2346 by 1568 pixels.
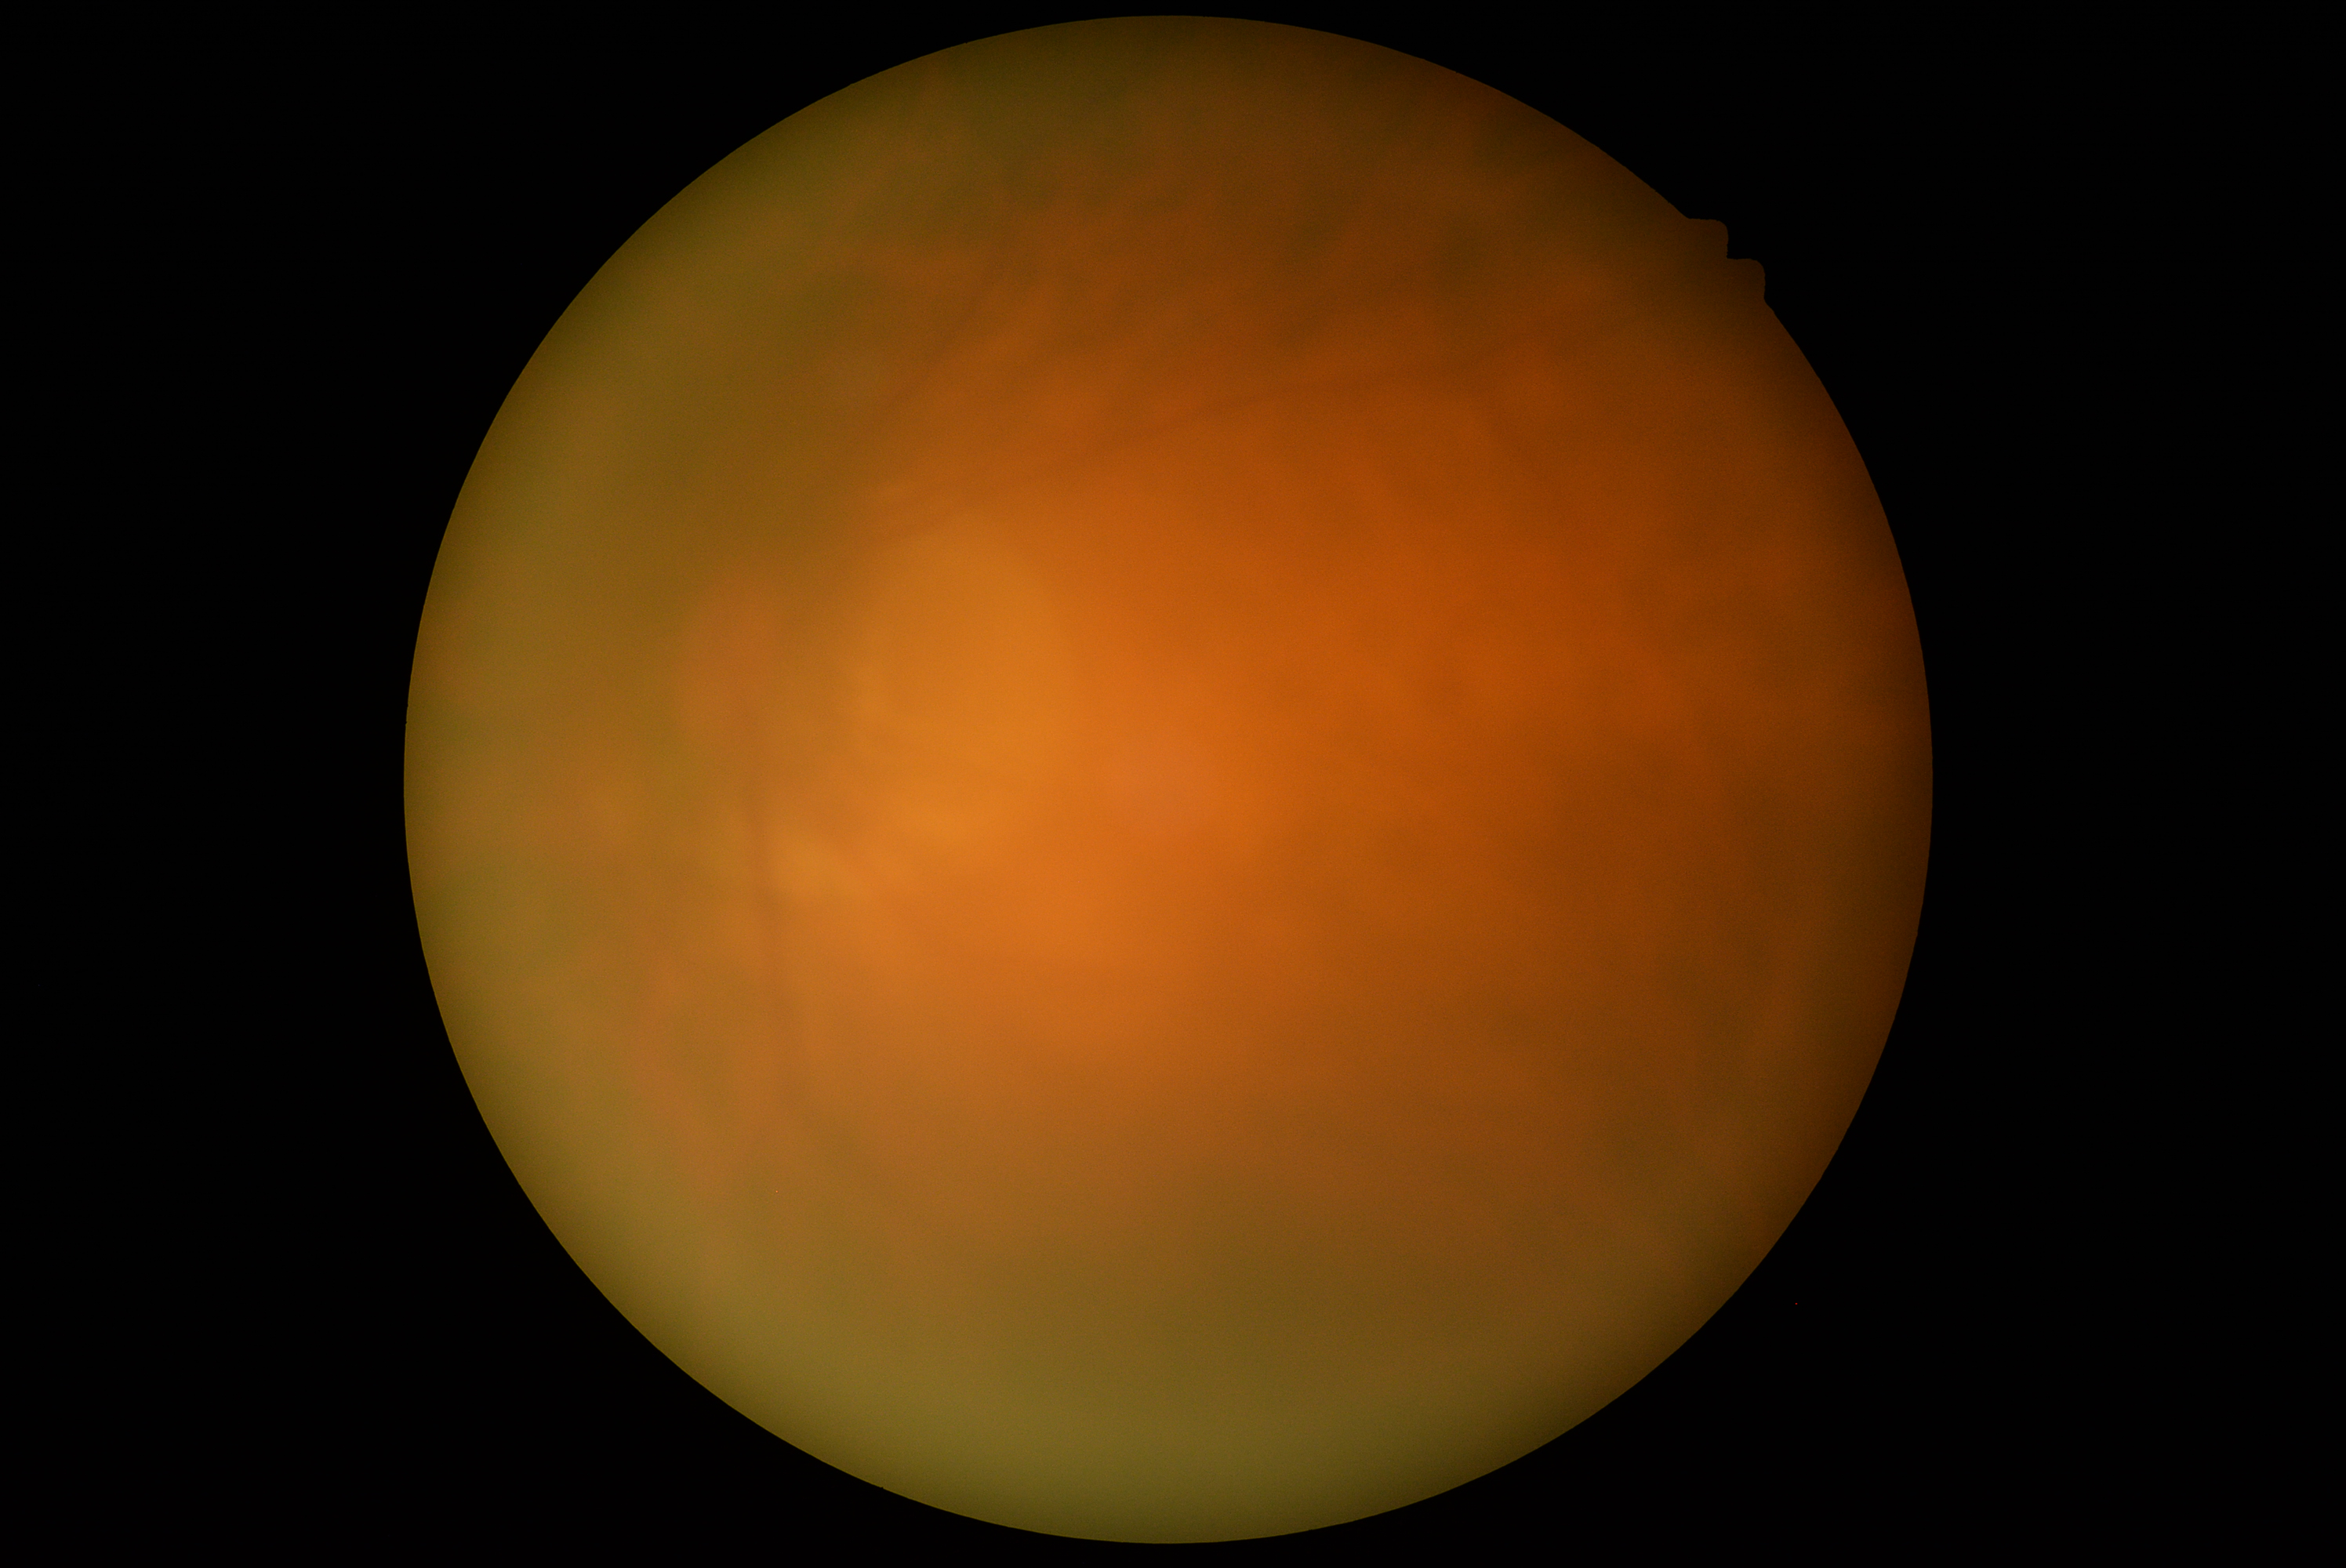 Diabetic retinopathy is ungradable due to poor image quality.